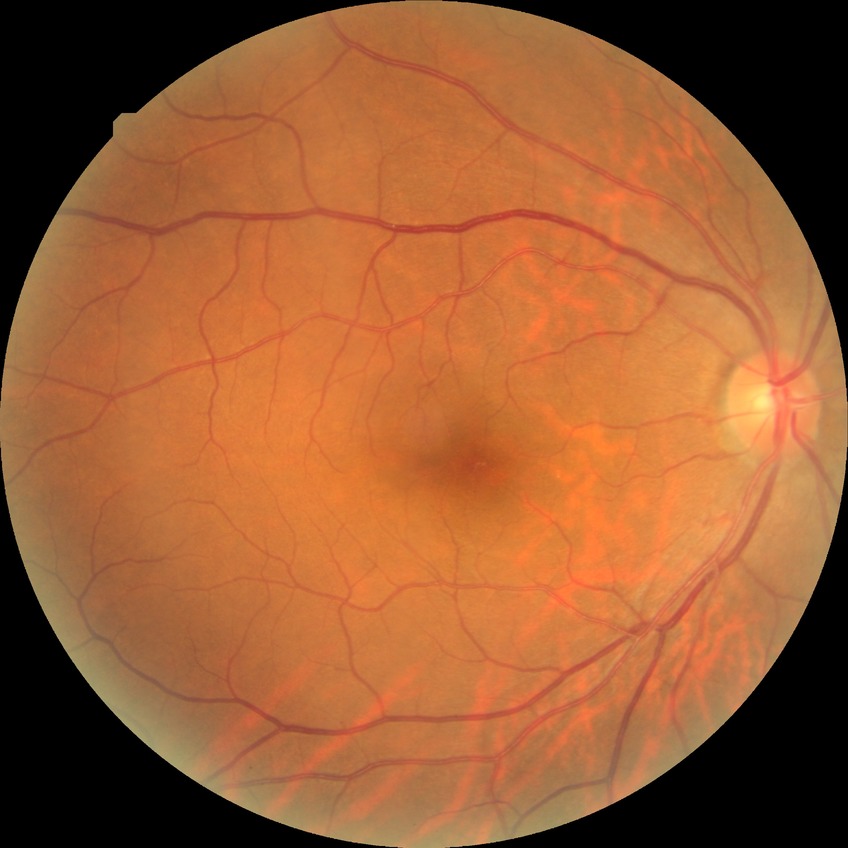
Diabetic retinopathy (DR) is NDR (no diabetic retinopathy).